FOV: 45 degrees
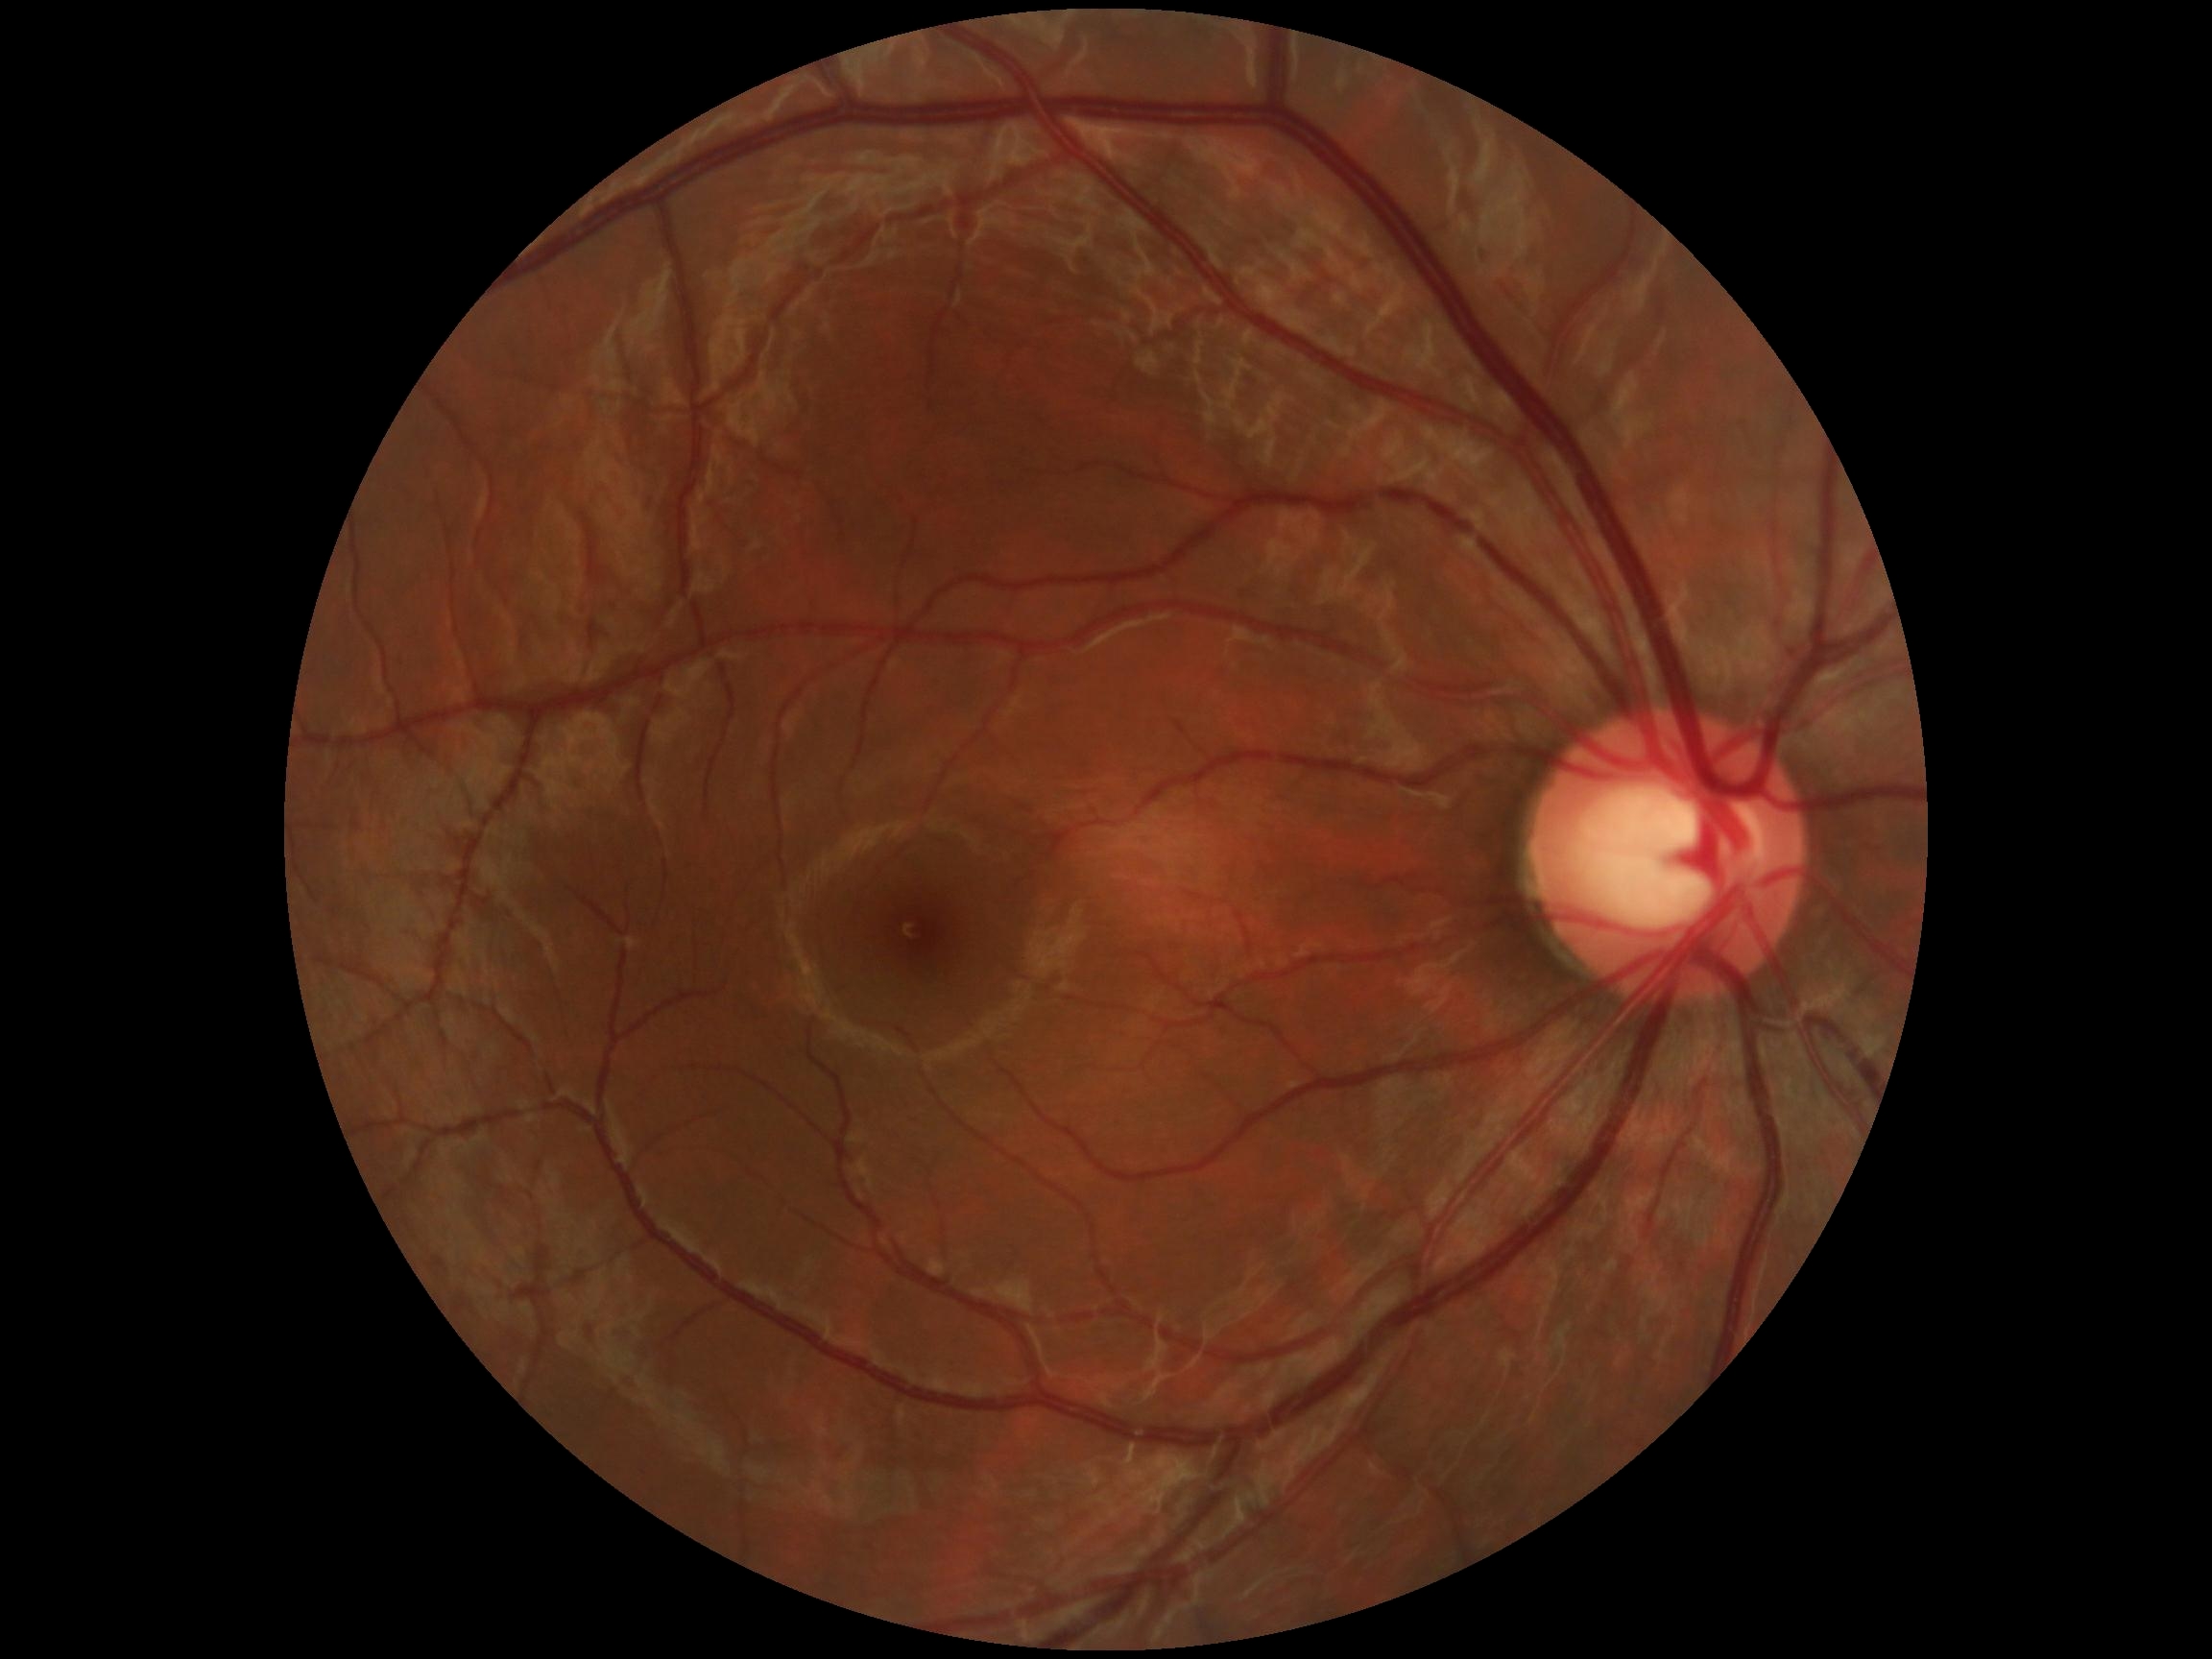 No apparent diabetic retinopathy.
DR: 0/4.